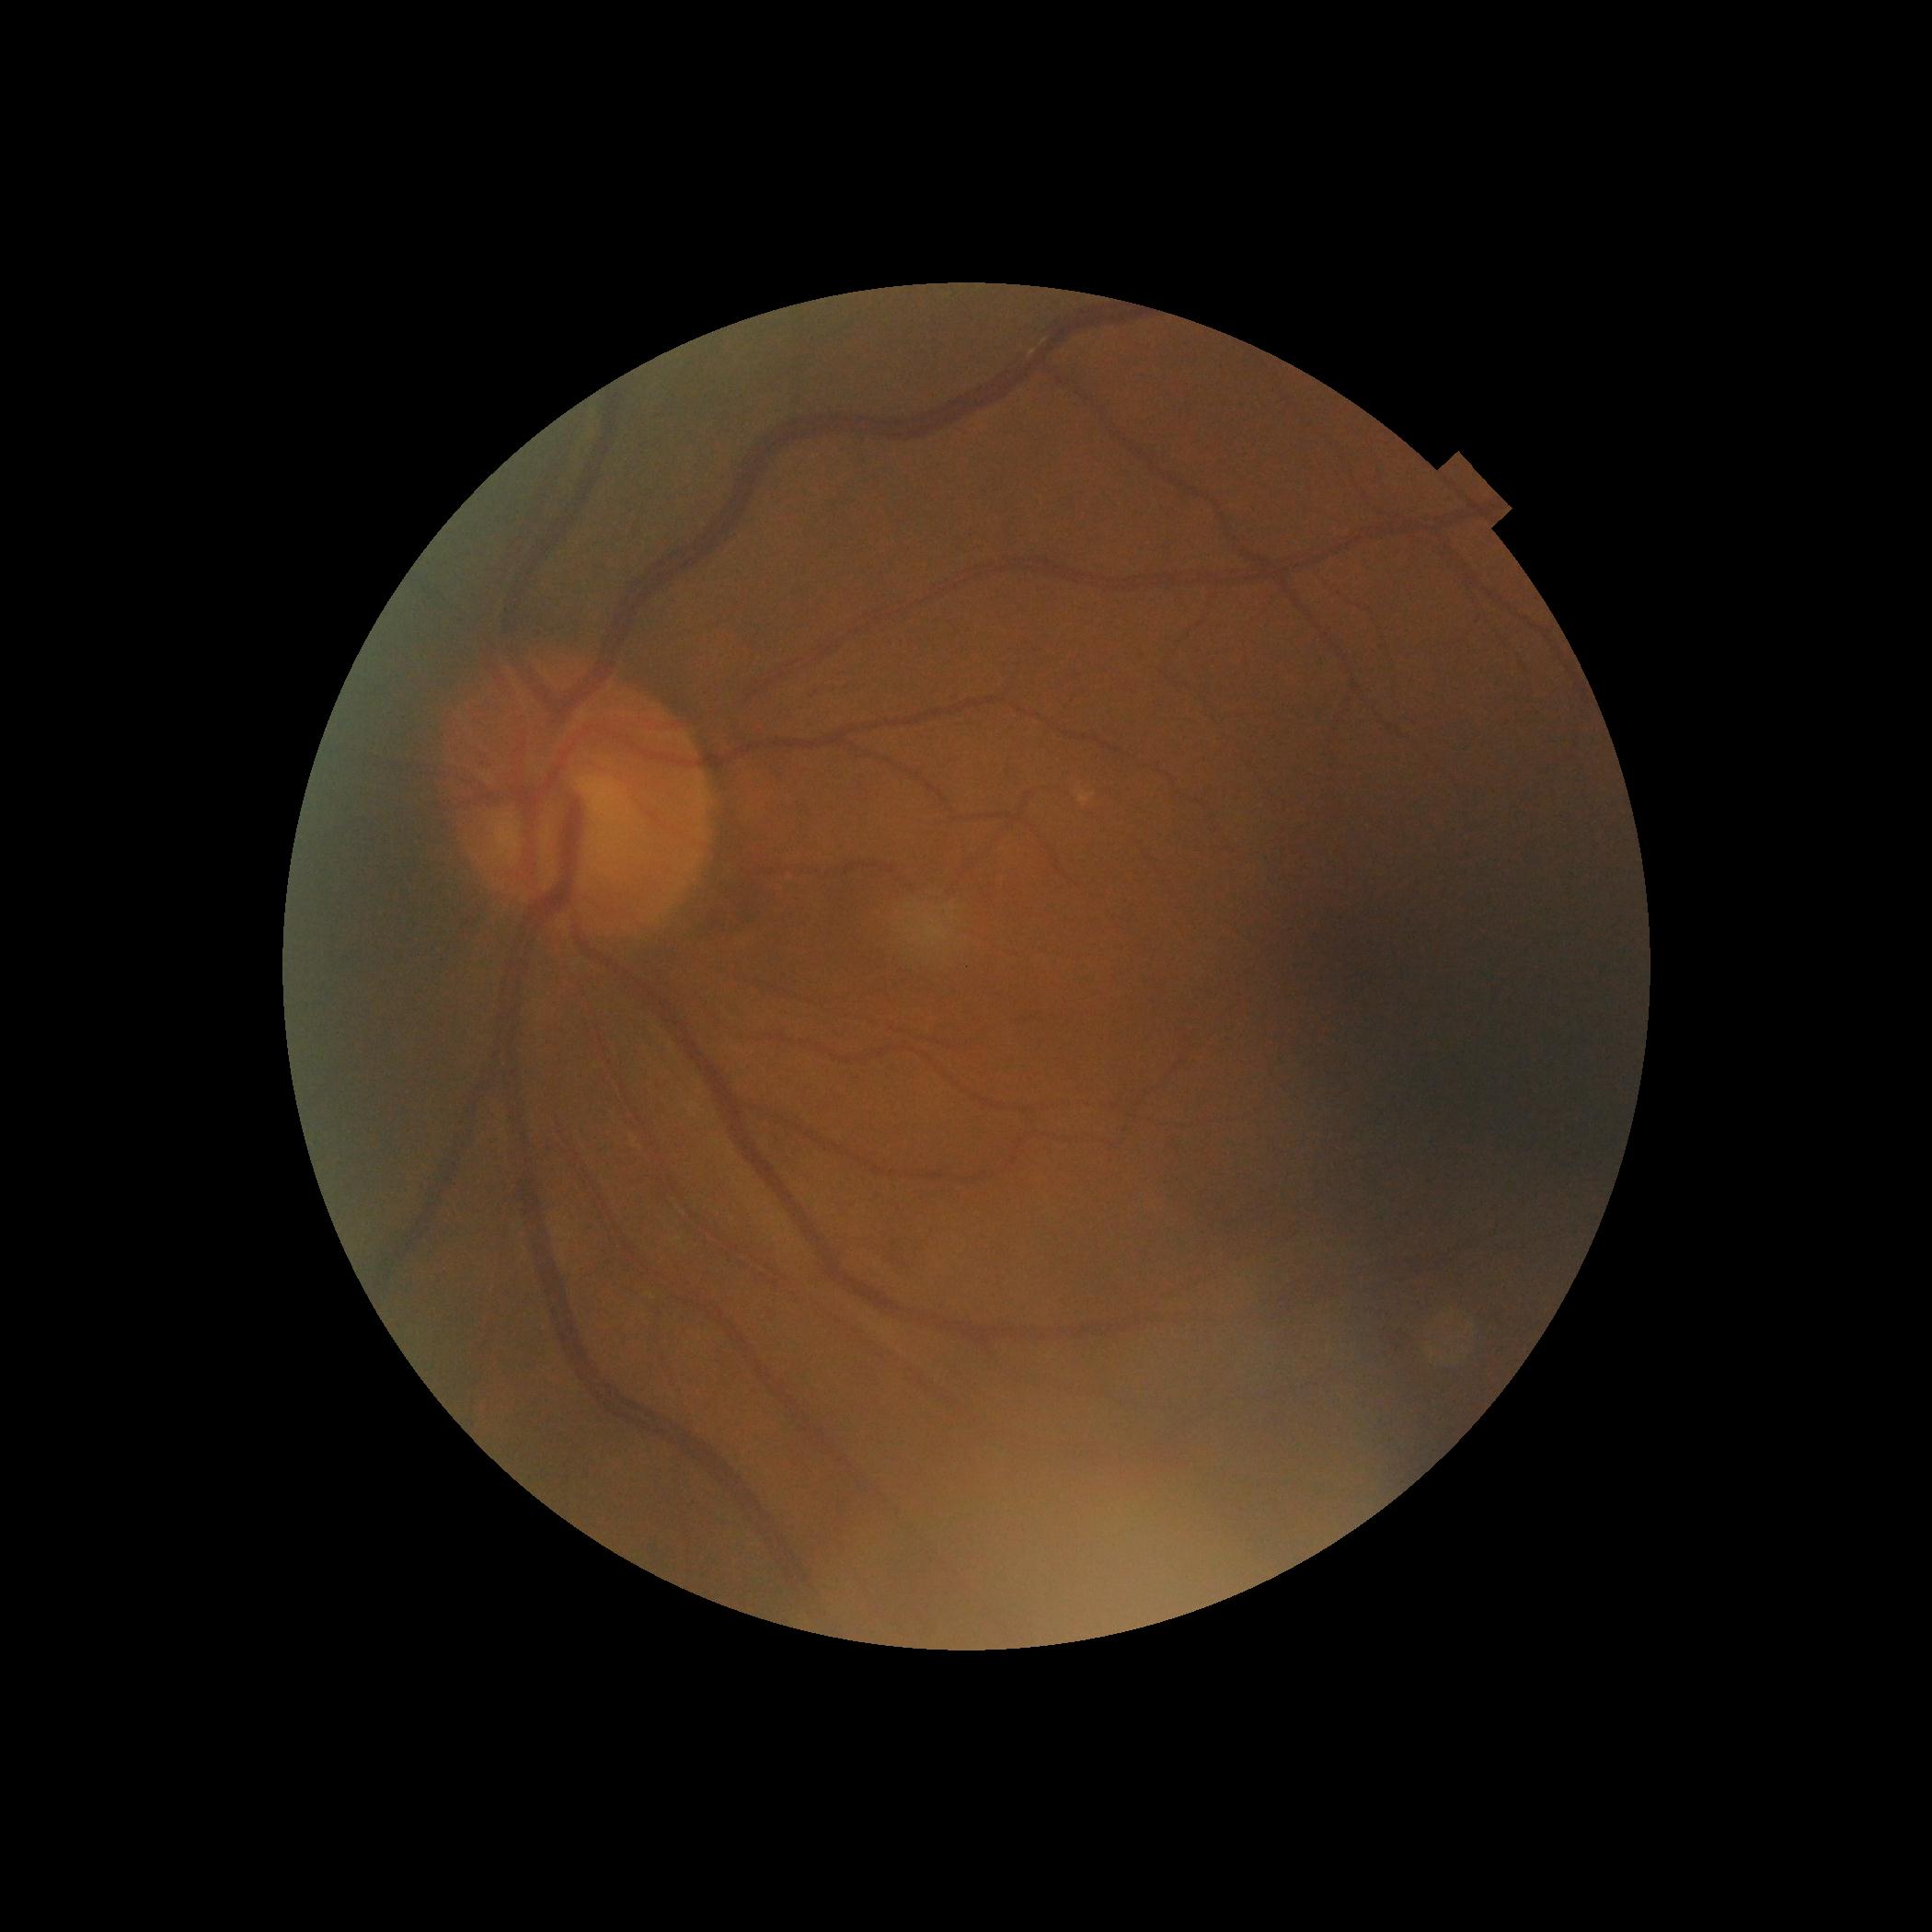

– DR impression: no signs of DR
– DR stage: 0/4